45-degree field of view · color fundus photograph — 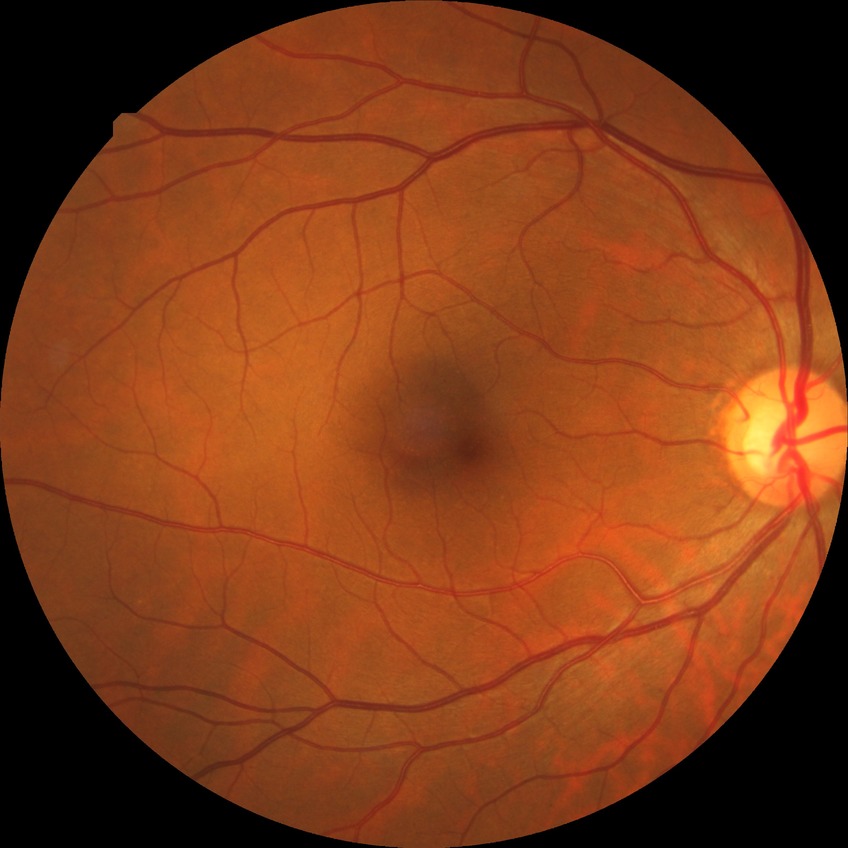

DR impression = no apparent DR, DR stage = NDR.